Diabetic retinopathy graded by the modified Davis classification
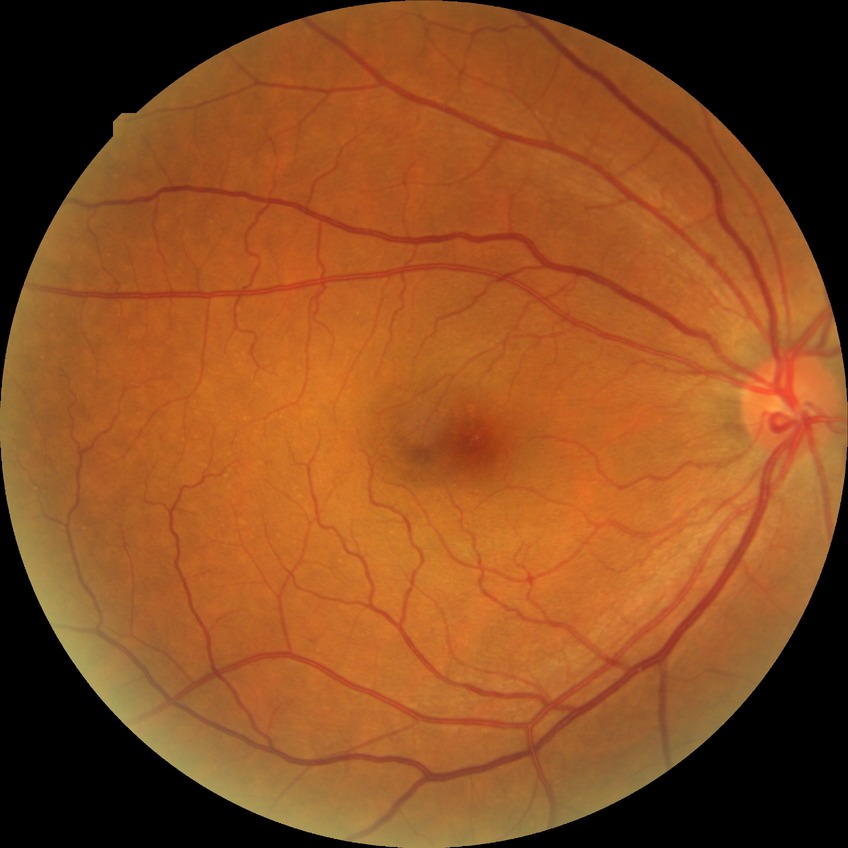

diabetic retinopathy stage = no diabetic retinopathy.